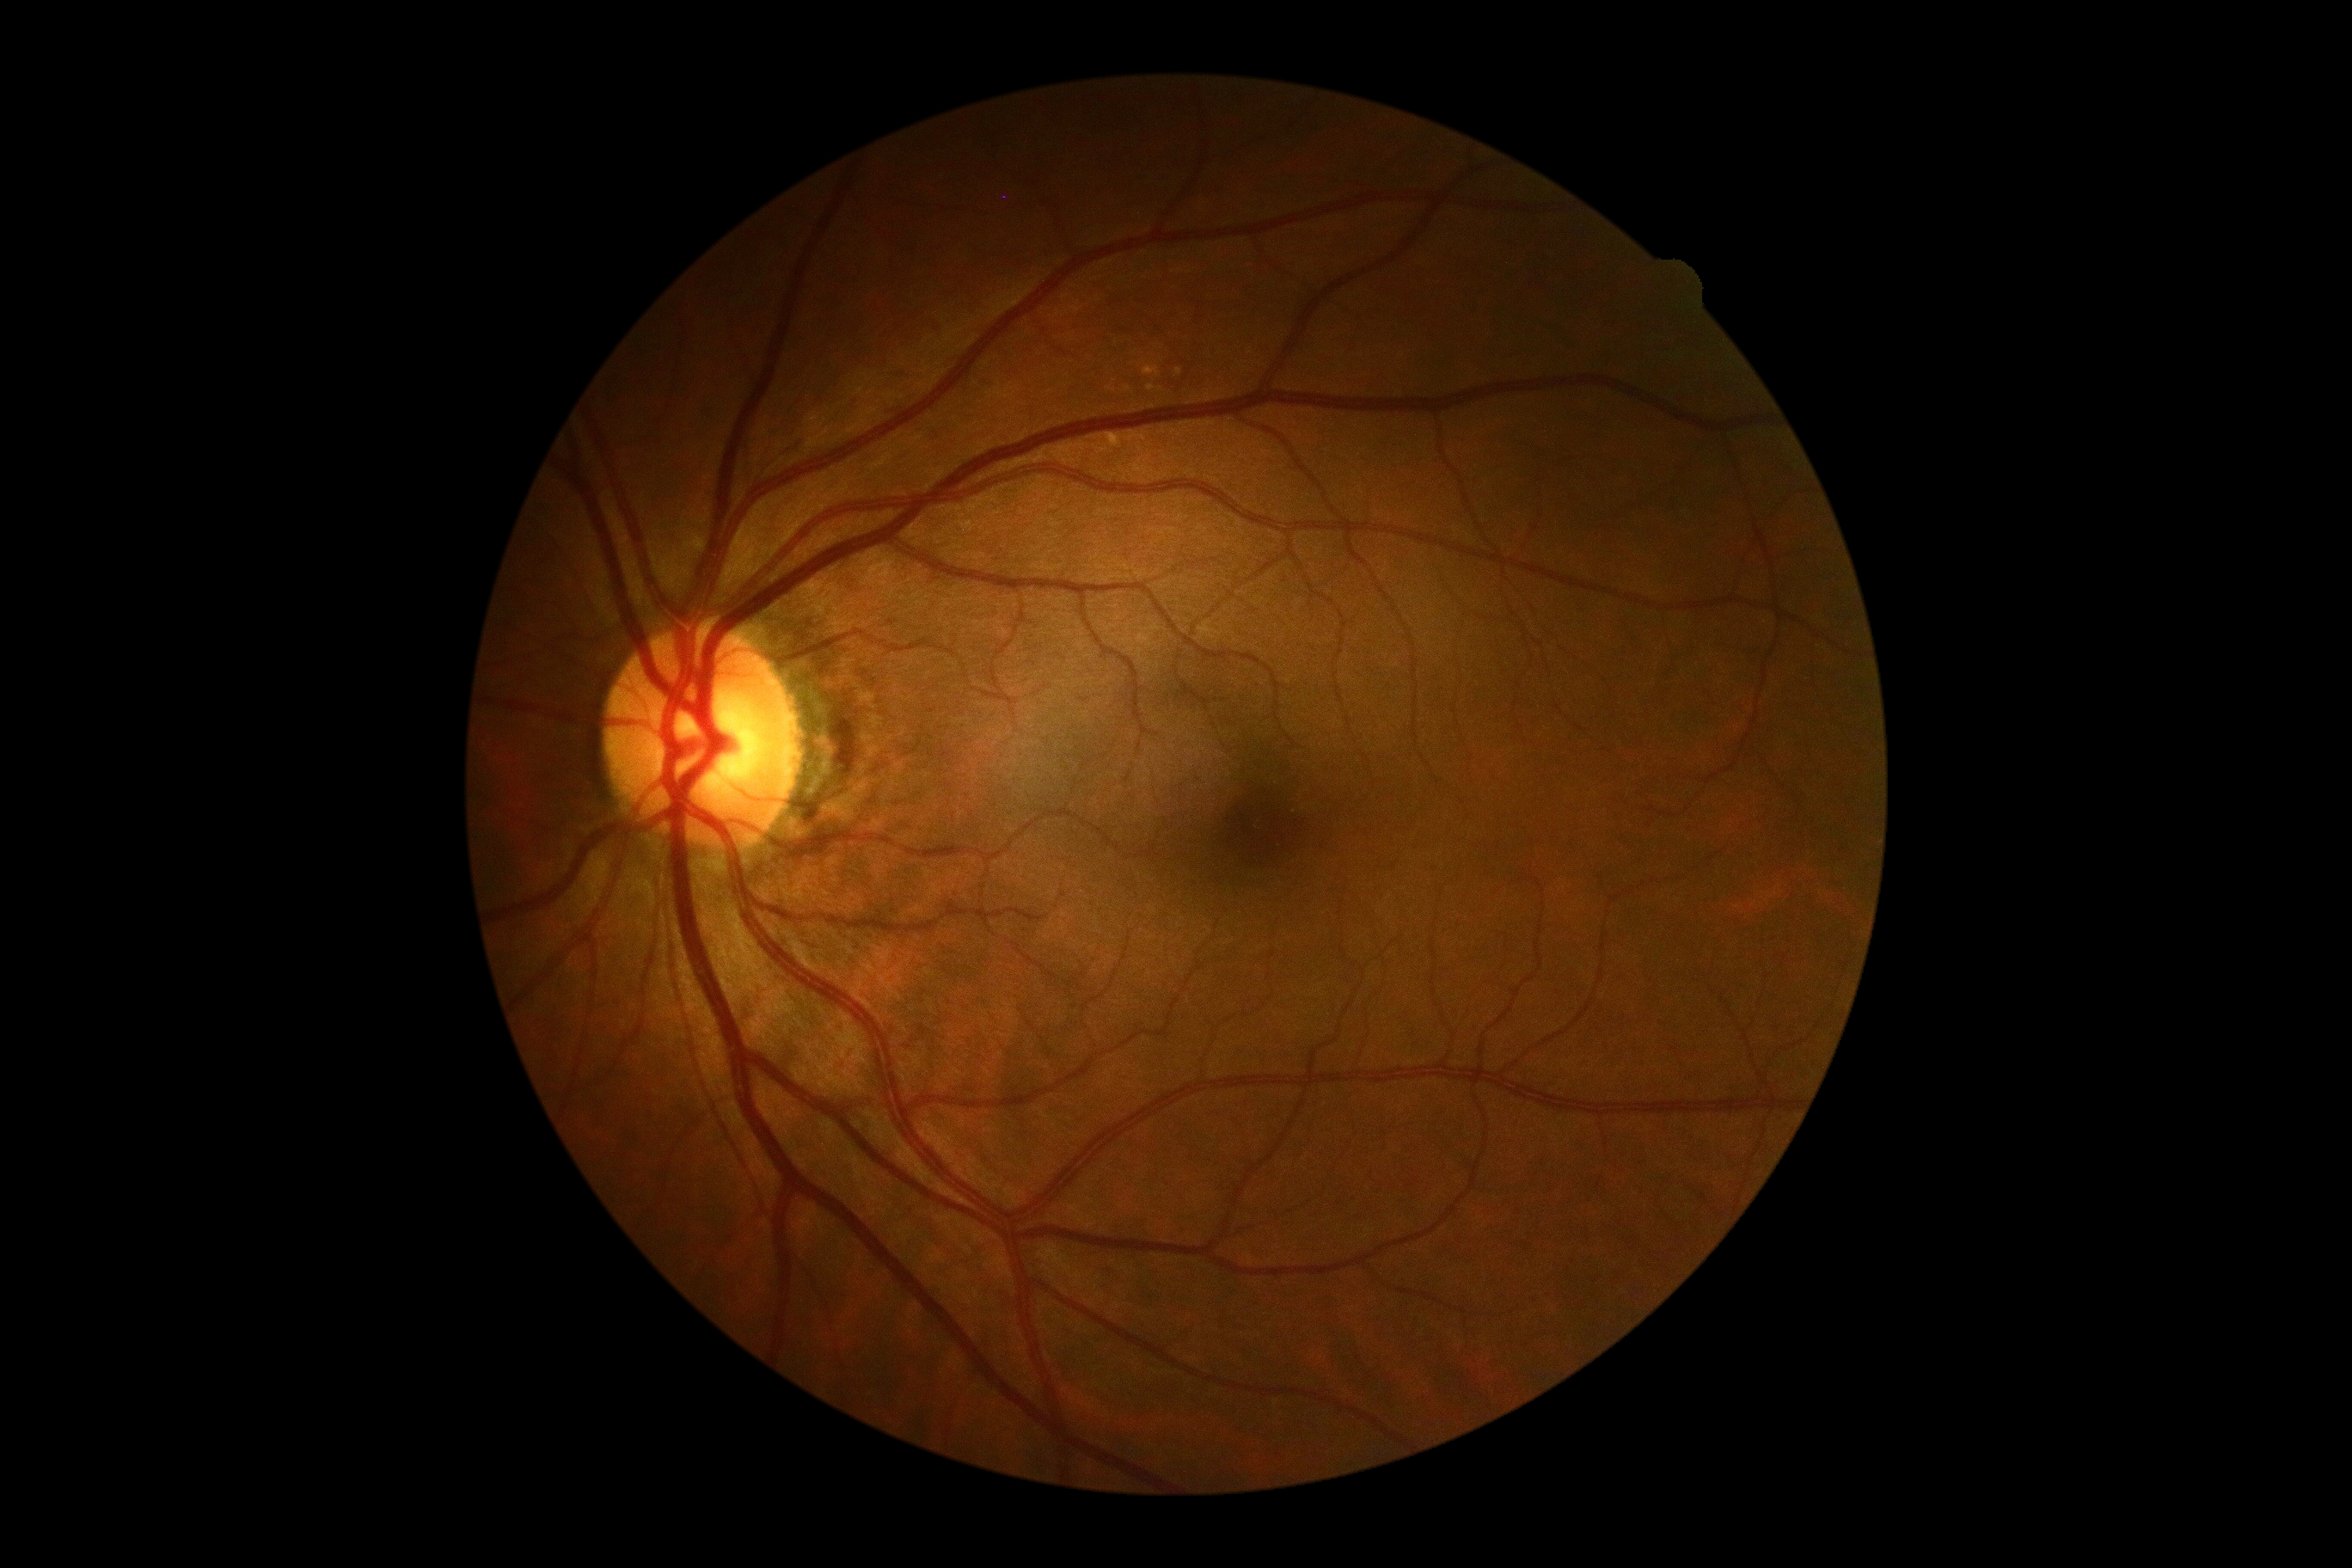

Retinopathy grade: 0/4.